100° field of view (Phoenix ICON) · 1240 by 1240 pixels · wide-field fundus photograph of an infant.
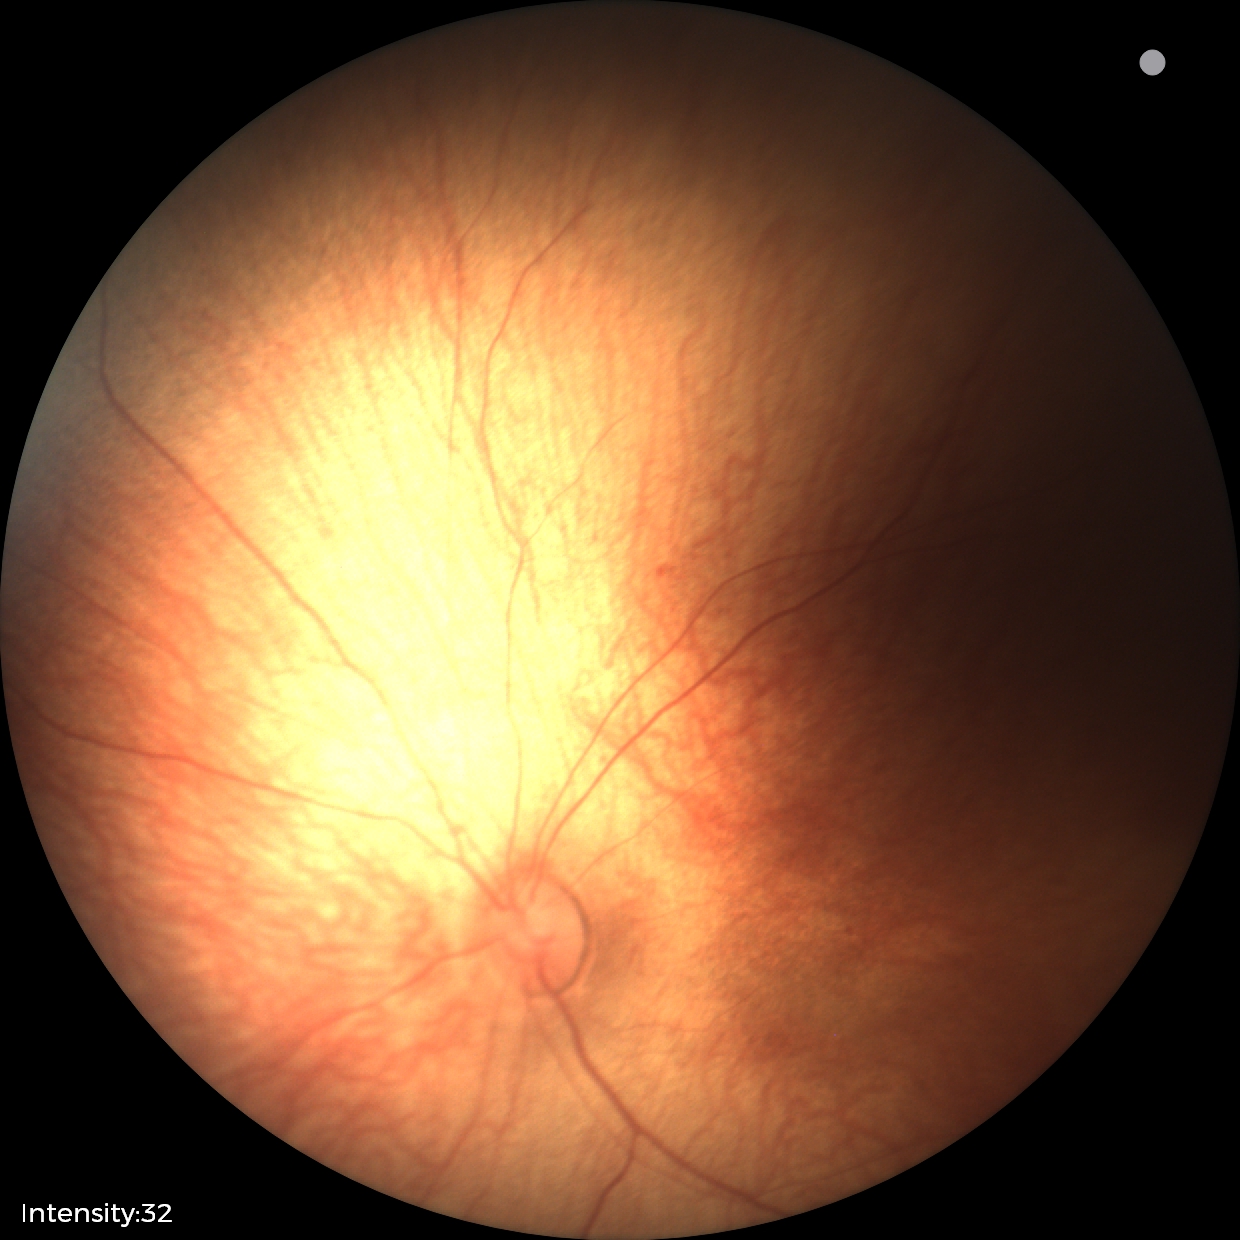 Impression: physiological appearance